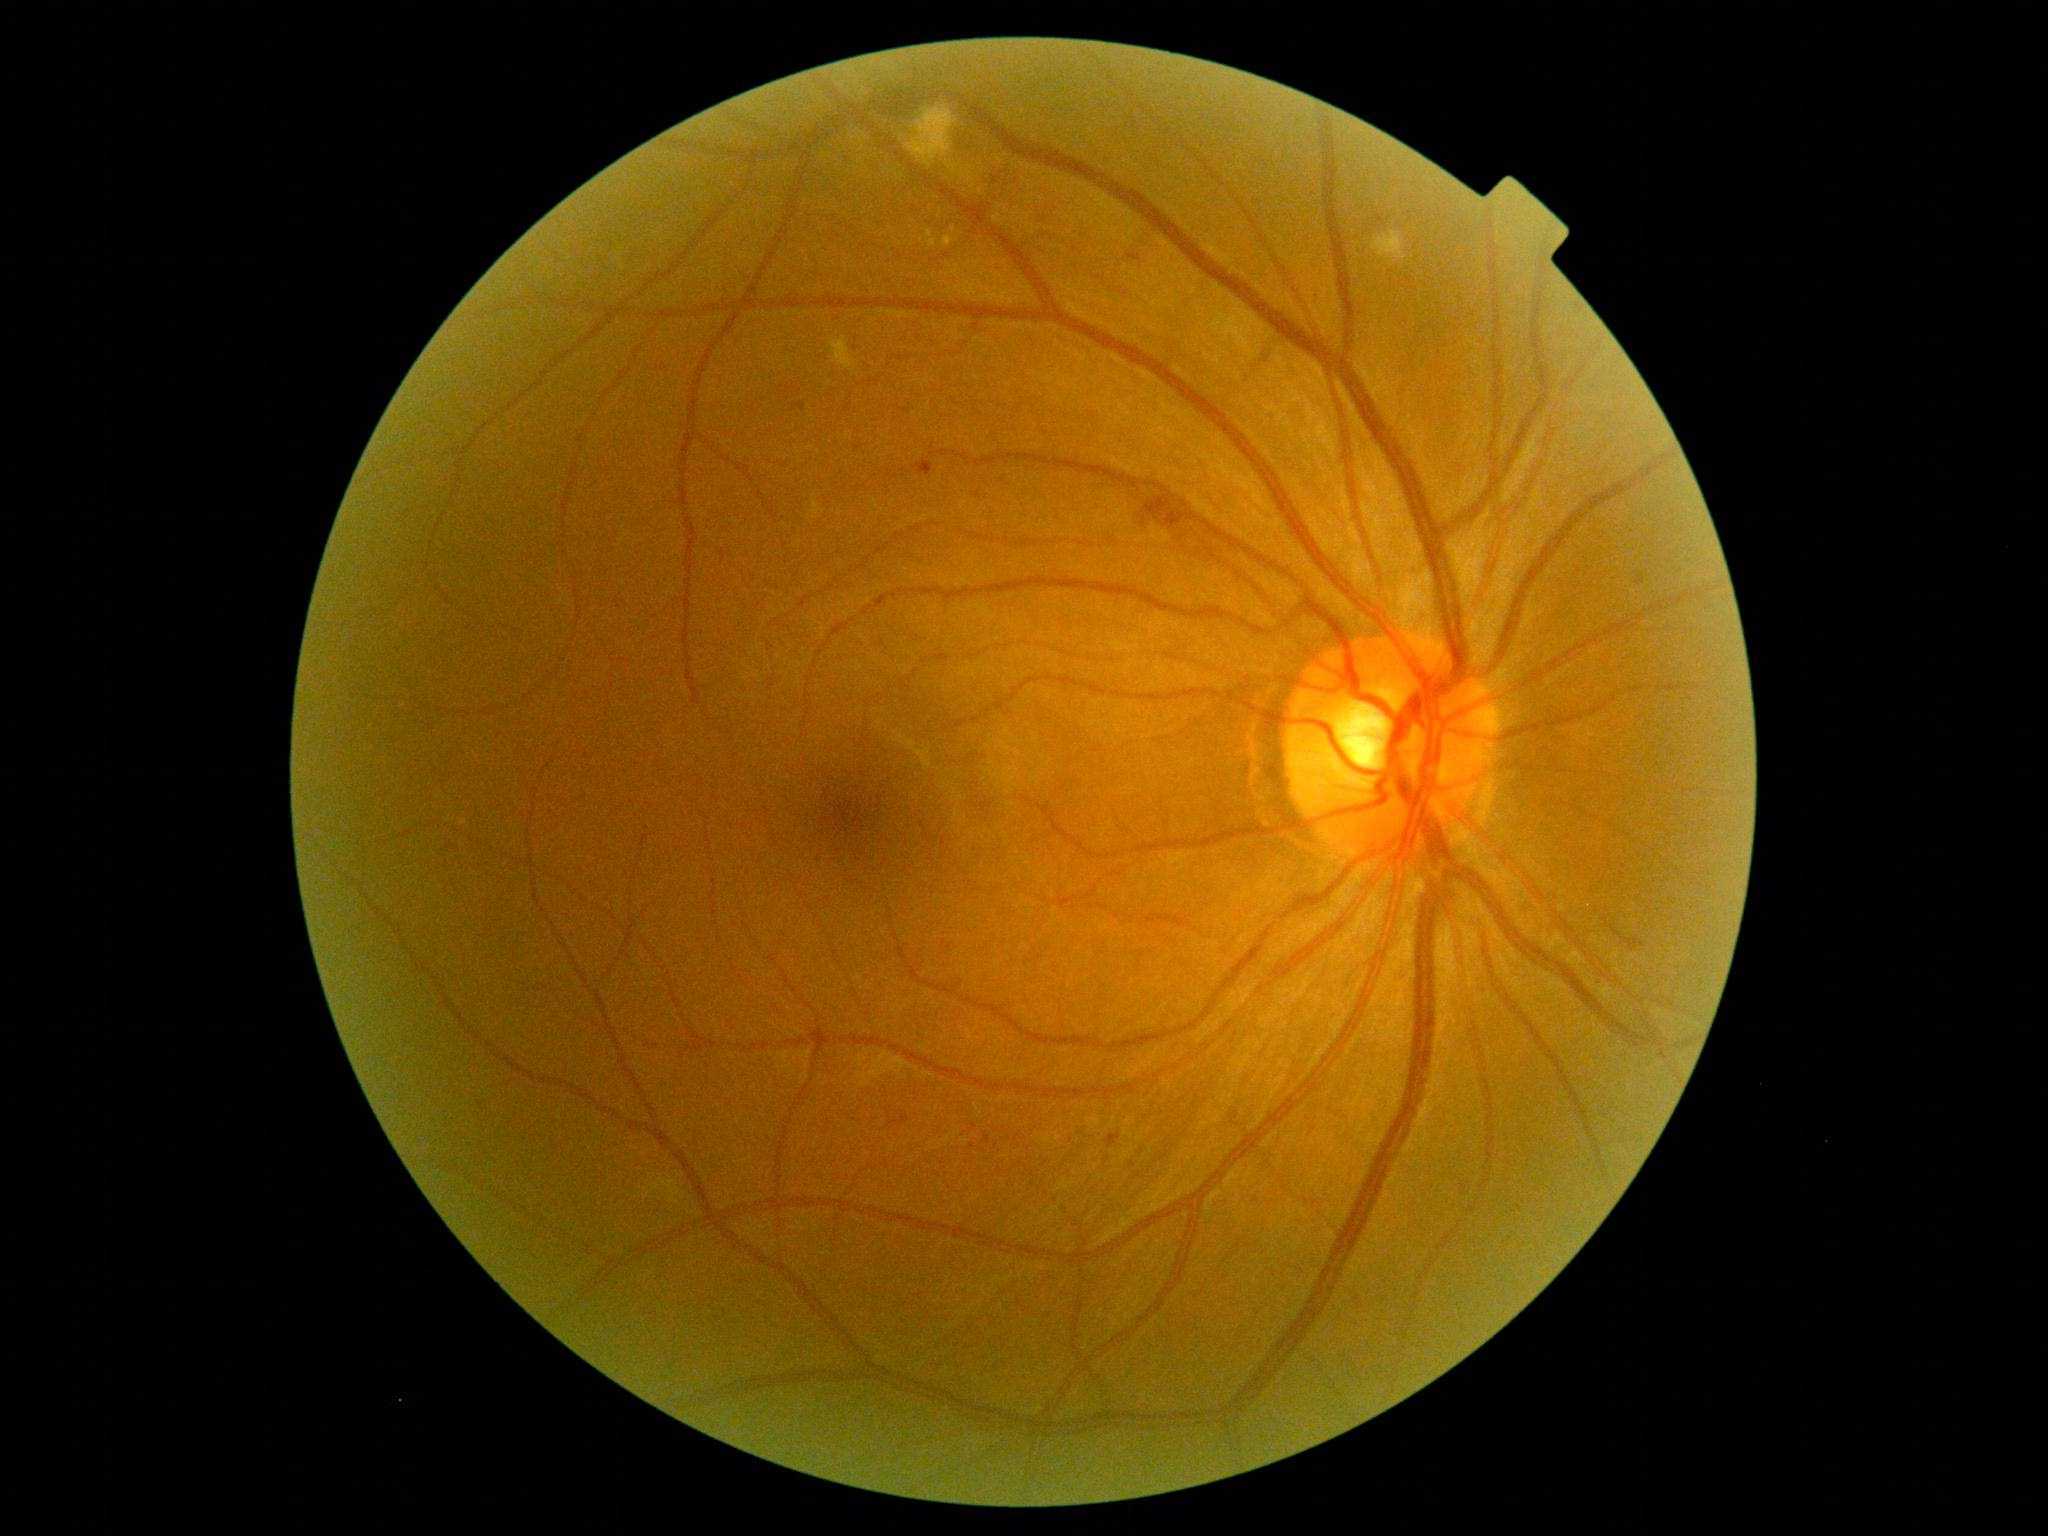

DR stage is moderate NPDR (grade 2); non-proliferative diabetic retinopathy. MAs found at <region>1106, 1134, 1122, 1148</region> | <region>1635, 575, 1645, 586</region> | <region>1127, 255, 1142, 262</region> | <region>792, 403, 807, 411</region> | <region>912, 460, 934, 476</region>. Additional small MAs near x=818, y=860. EXs include those at <region>925, 231, 938, 249</region> | <region>942, 235, 954, 248</region> | <region>938, 209, 942, 218</region>. Additional small EXs near x=922, y=241 | x=954, y=229. SEs found at <region>829, 337, 858, 377</region> | <region>905, 106, 958, 169</region> | <region>1373, 231, 1407, 261</region>. HEs found at <region>1142, 496, 1196, 535</region>.